Infant wide-field fundus photograph · 130° field of view (Clarity RetCam 3) · 640 by 480 pixels
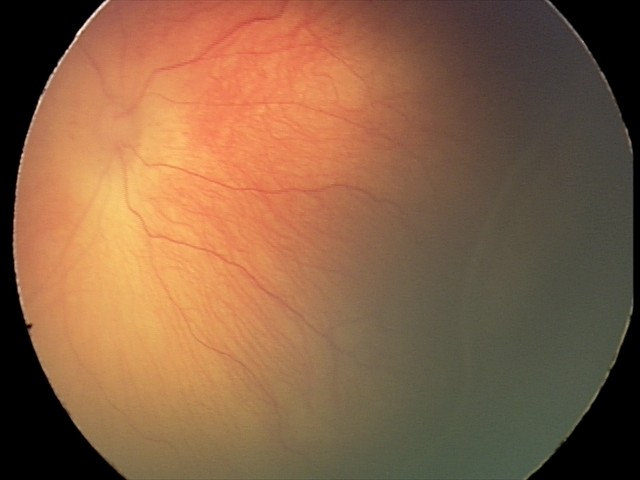

Plus form = absent, assessment = ROP stage 2.